Color fundus image · image size 1659x2212 · acquired with a Remidio Fundus on Phone.
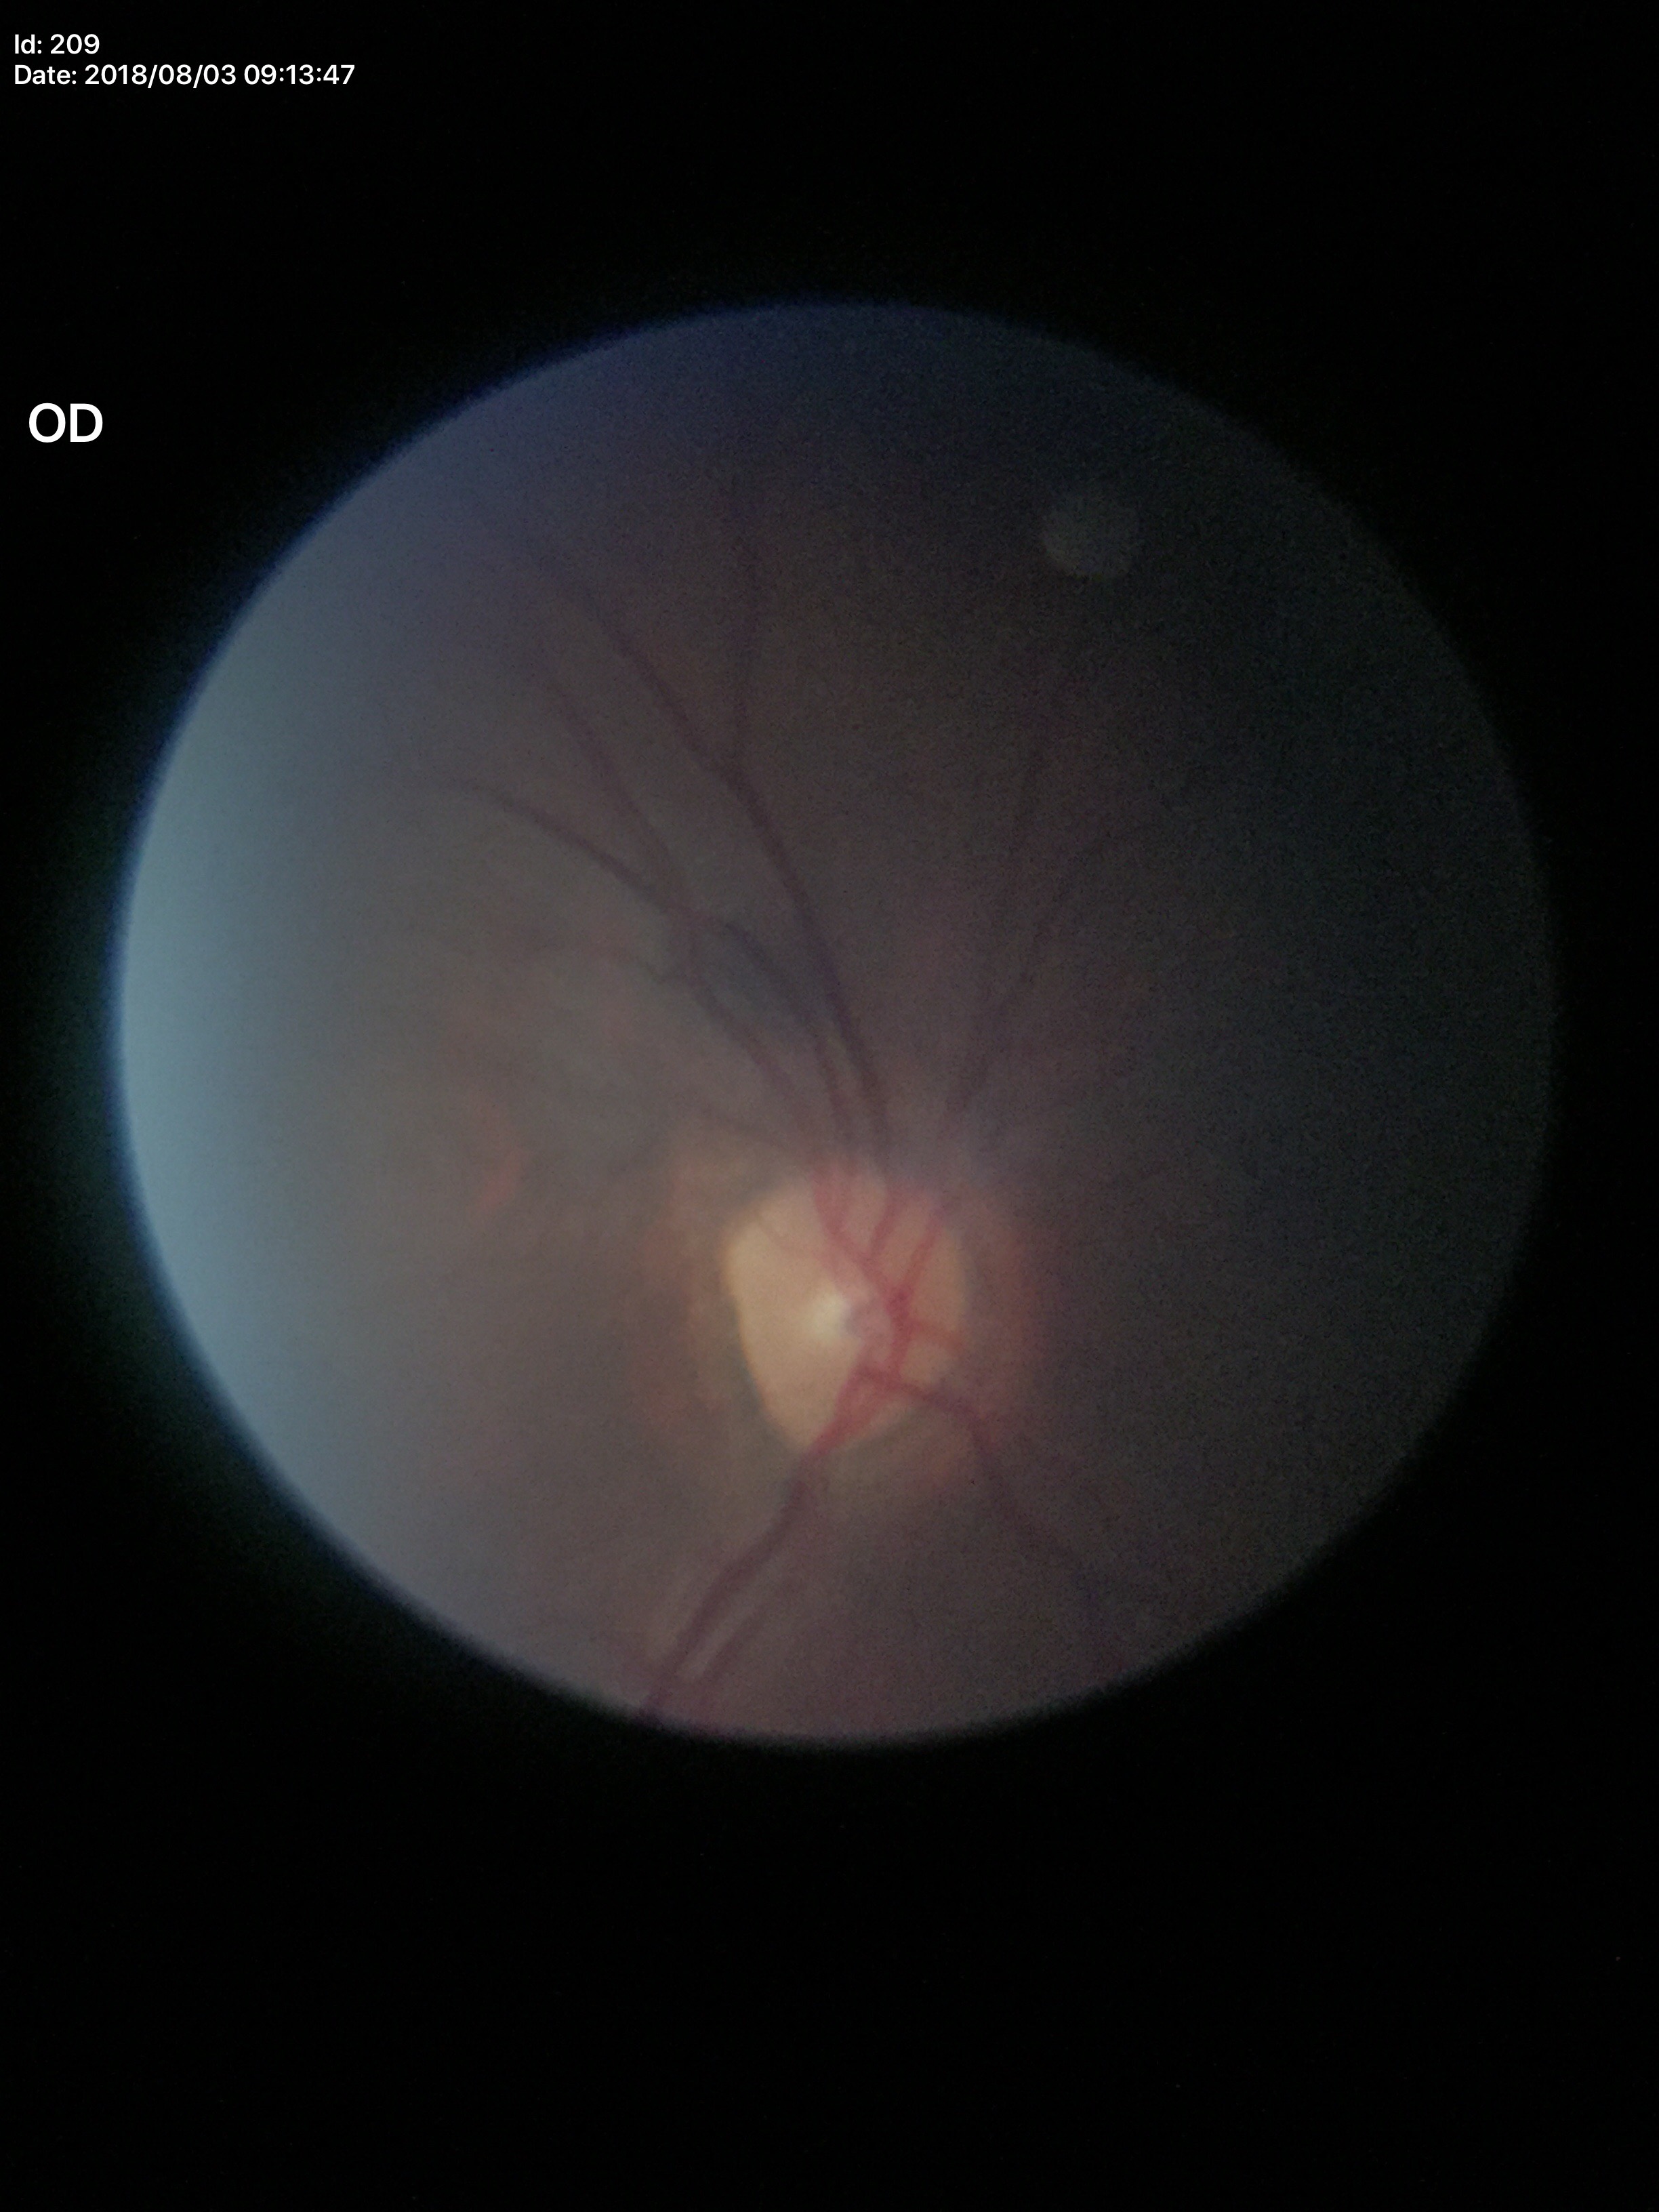
Not suspicious for glaucoma. Vertical C/D ratio: 0.35.